Nonmydriatic; fundus photo
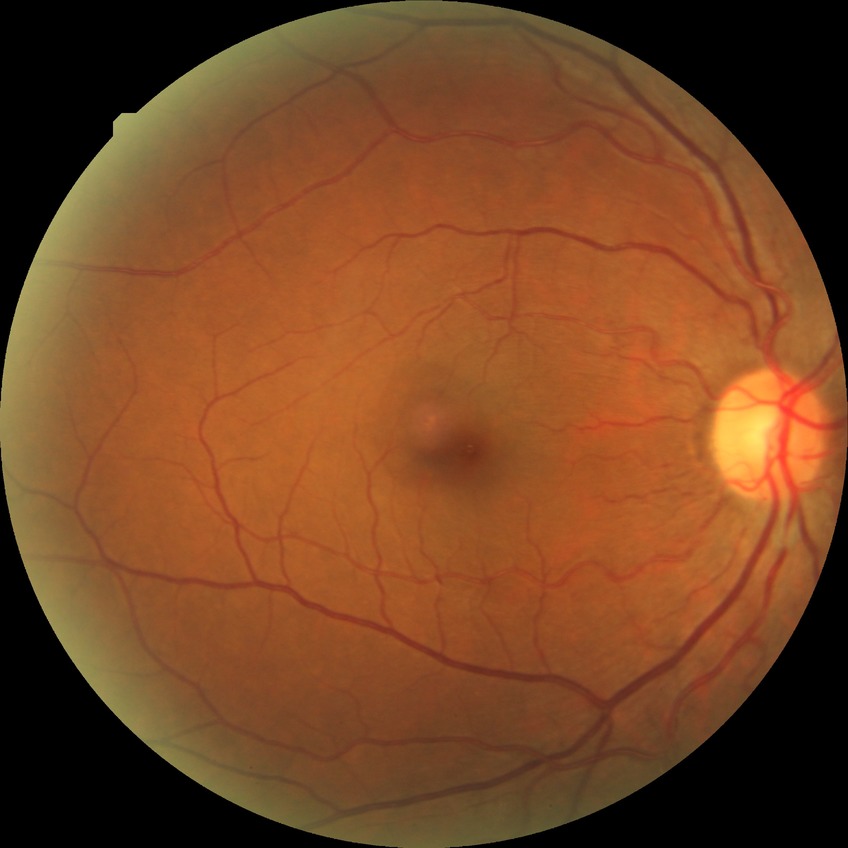
modified Davis classification: simple diabetic retinopathy.